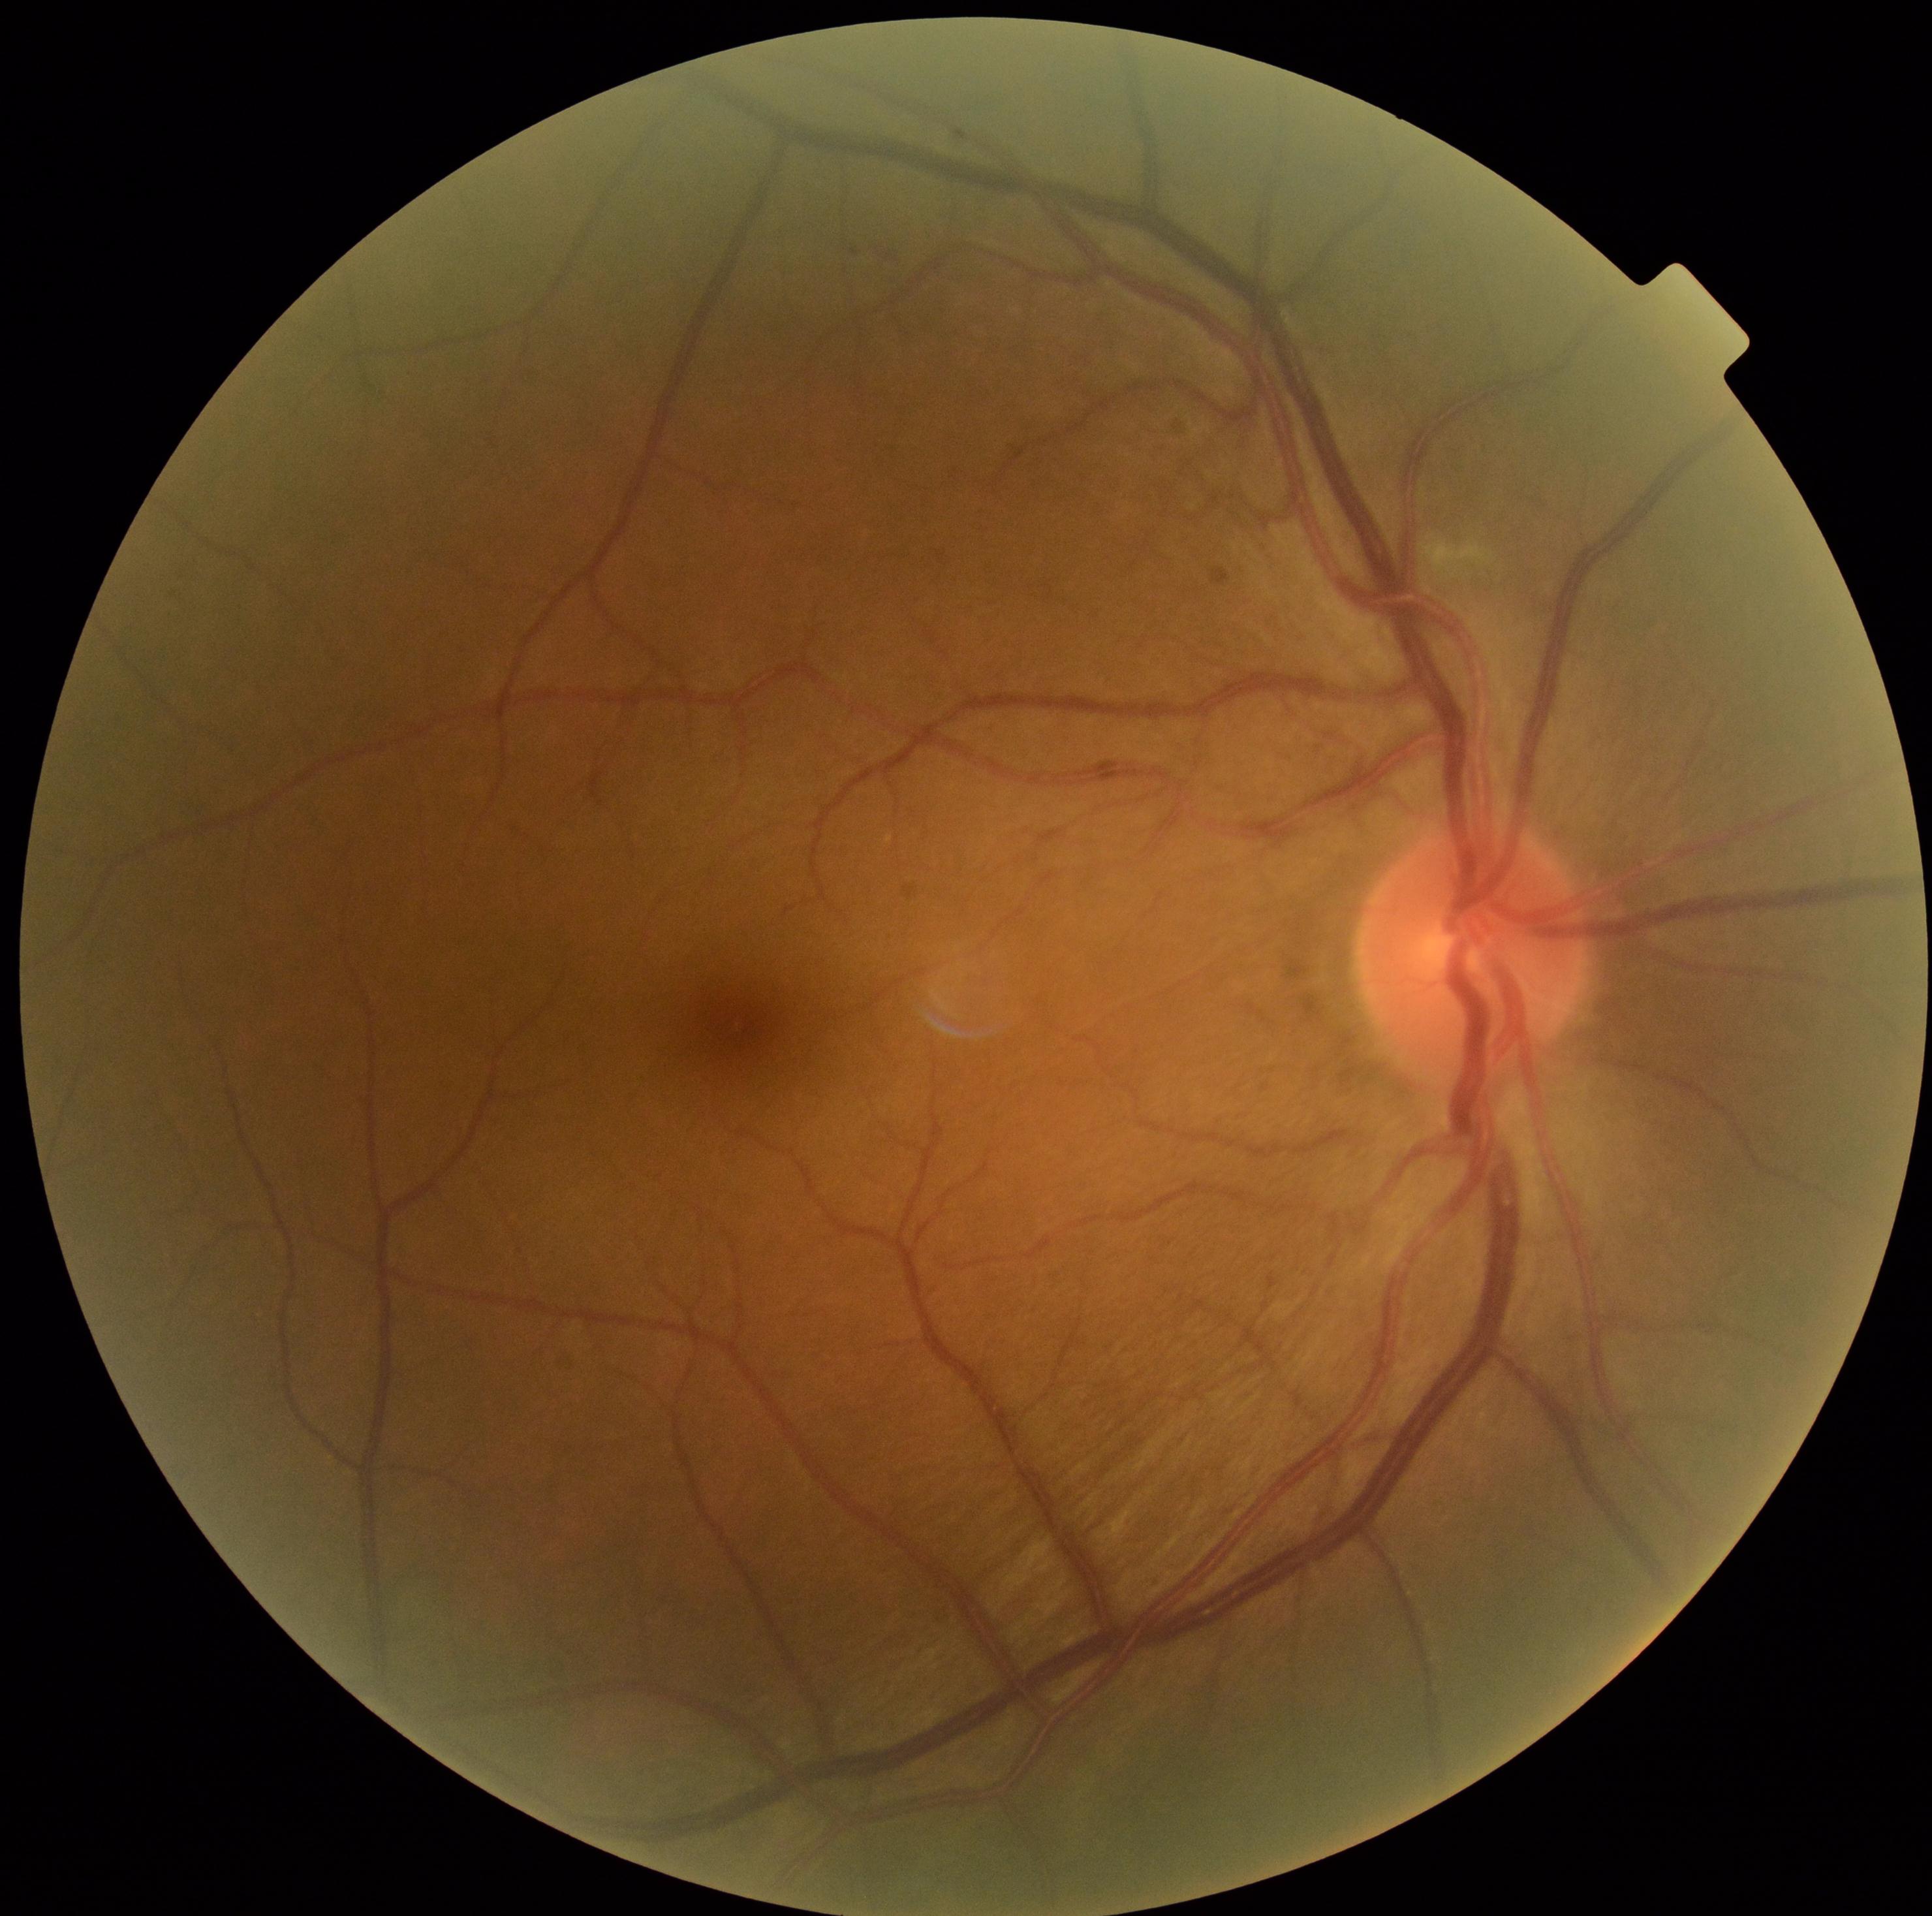
DR grade: moderate non-proliferative diabetic retinopathy (2).